1240x1240px; infant wide-field retinal image; 100° field of view (Phoenix ICON) — 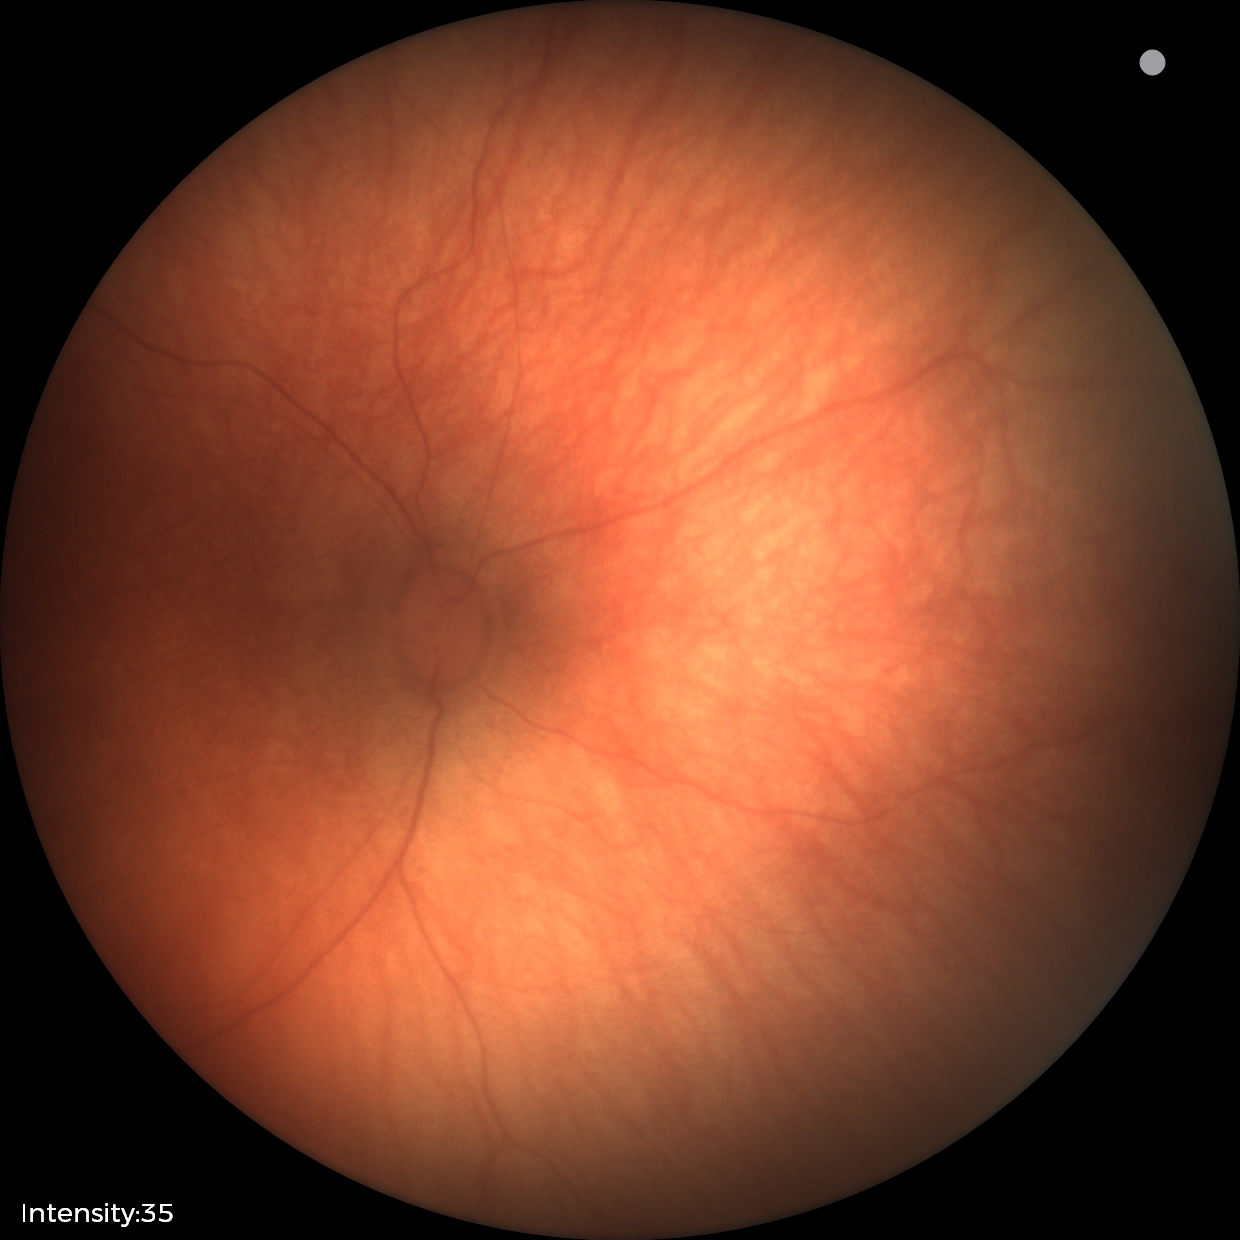 Impression = no abnormalities.